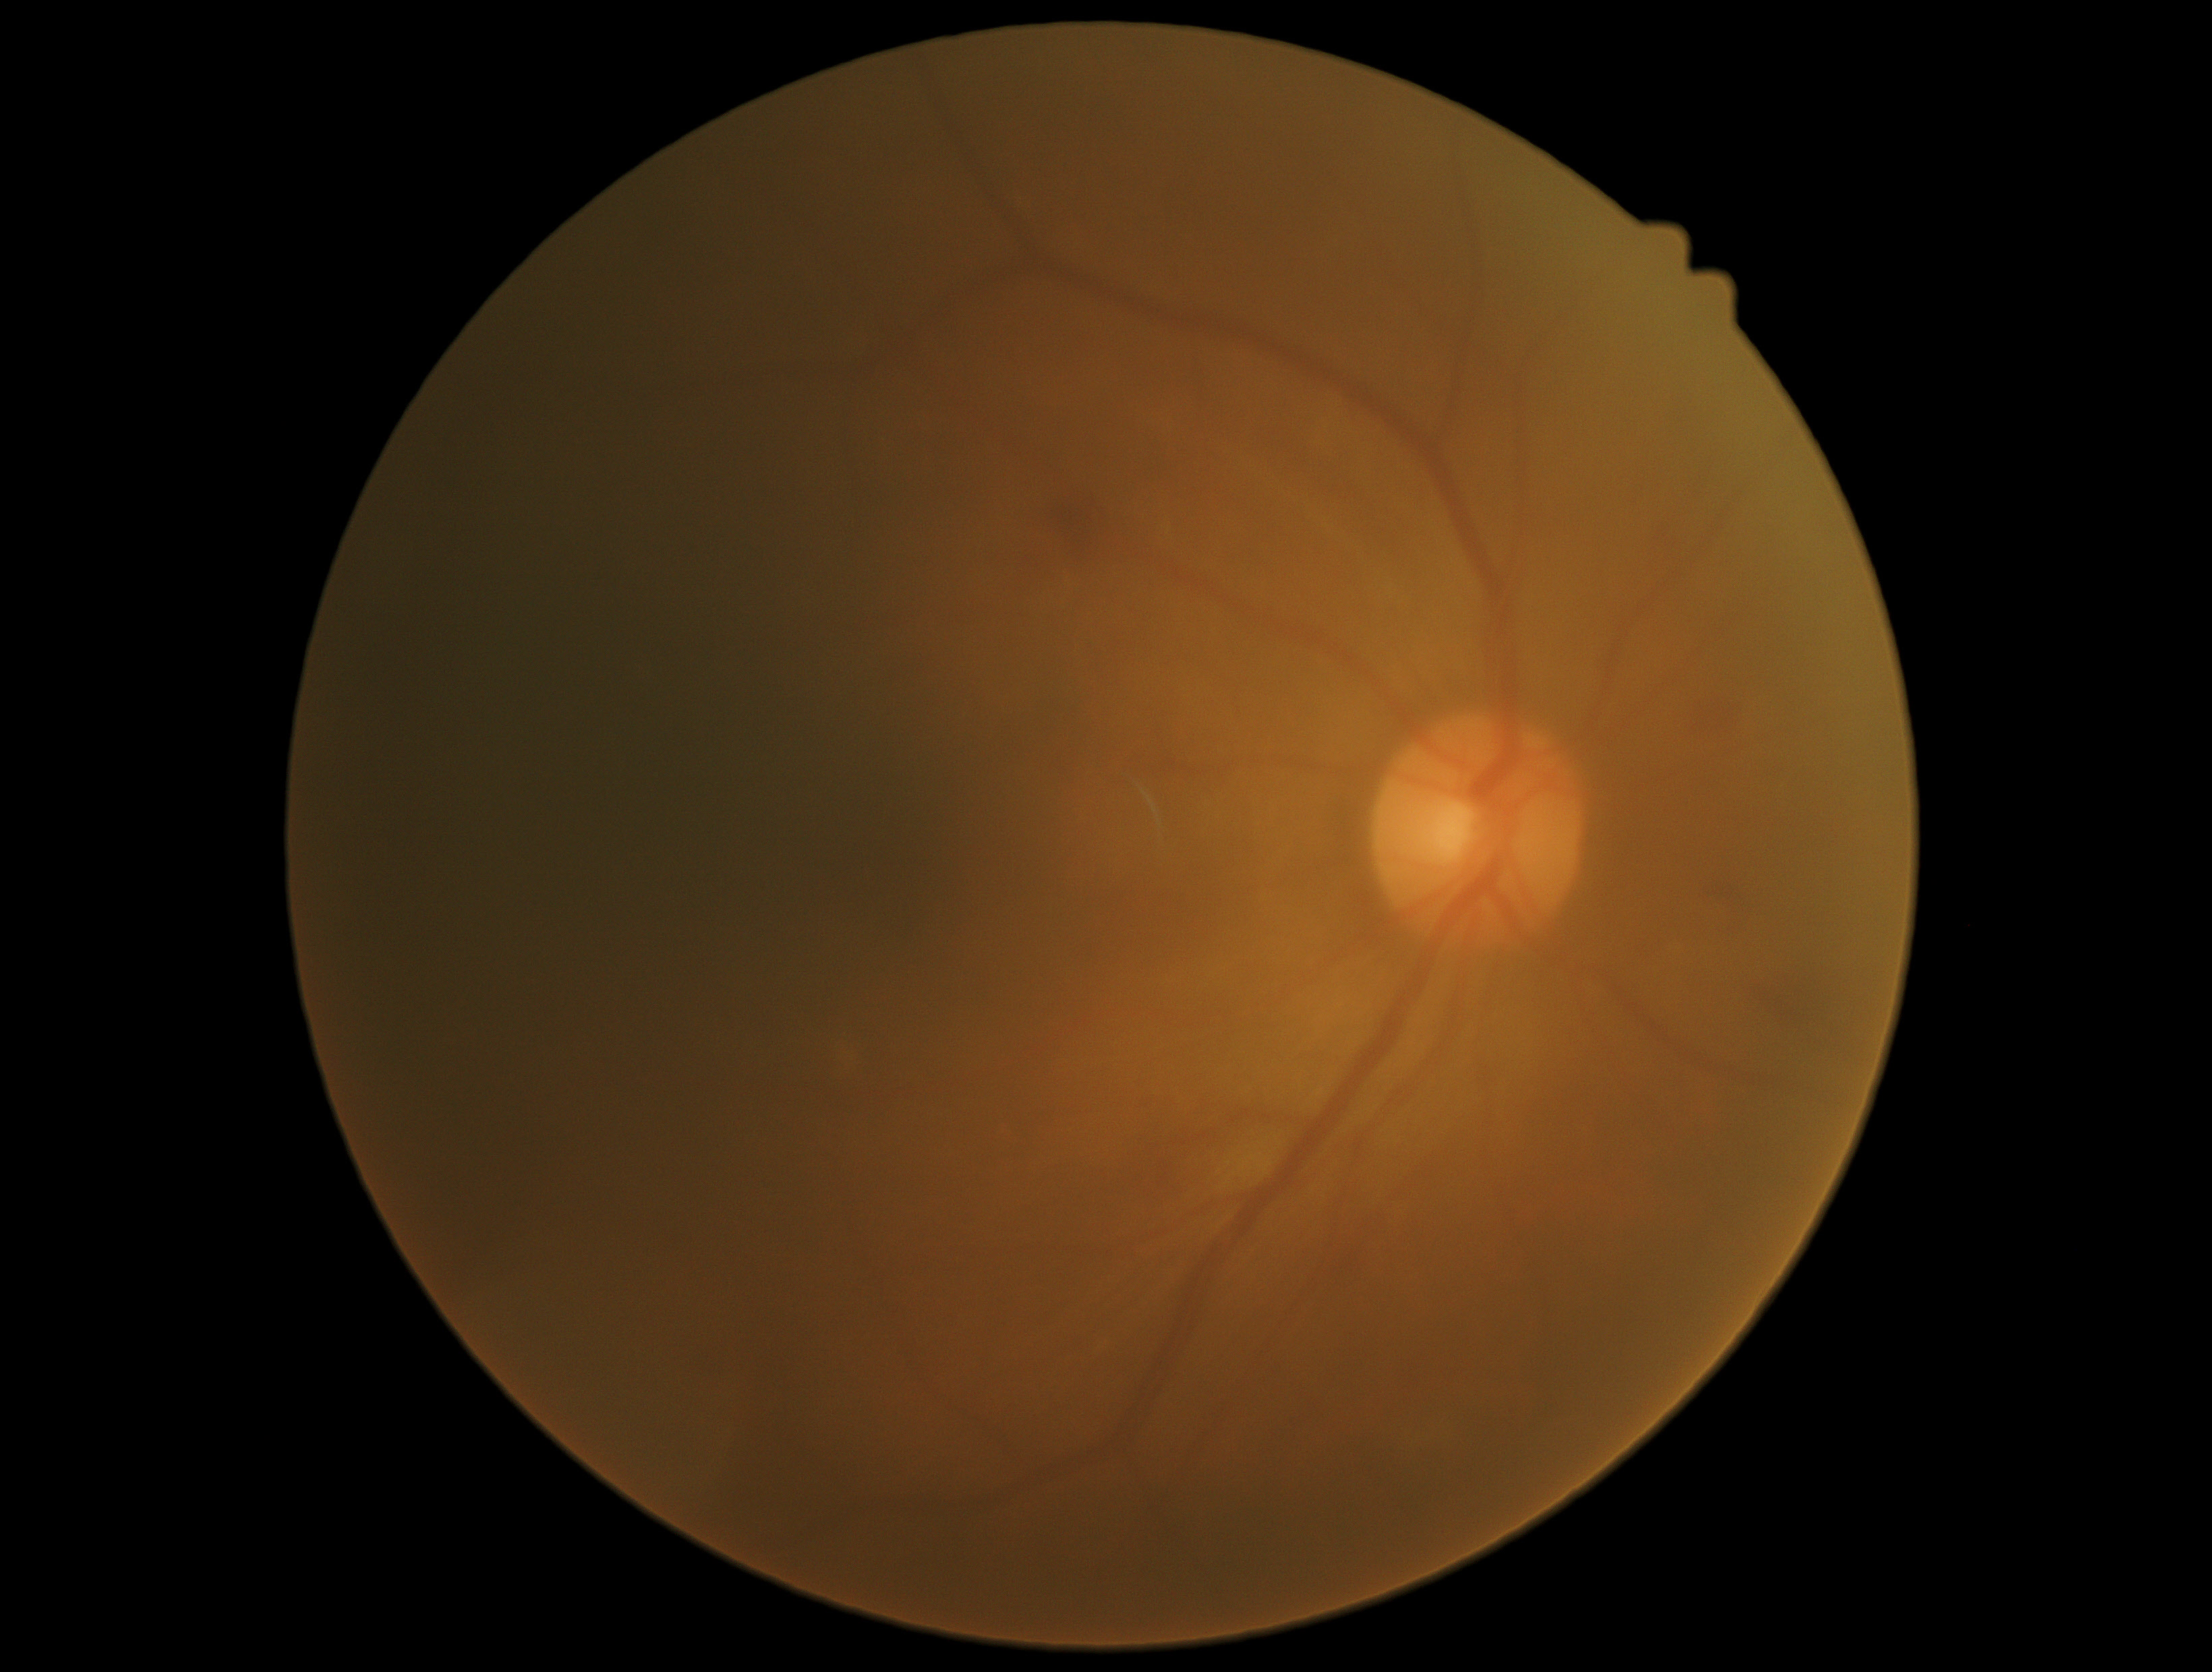 Diabetic retinopathy is moderate NPDR (grade 2).